NIDEK AFC-230:
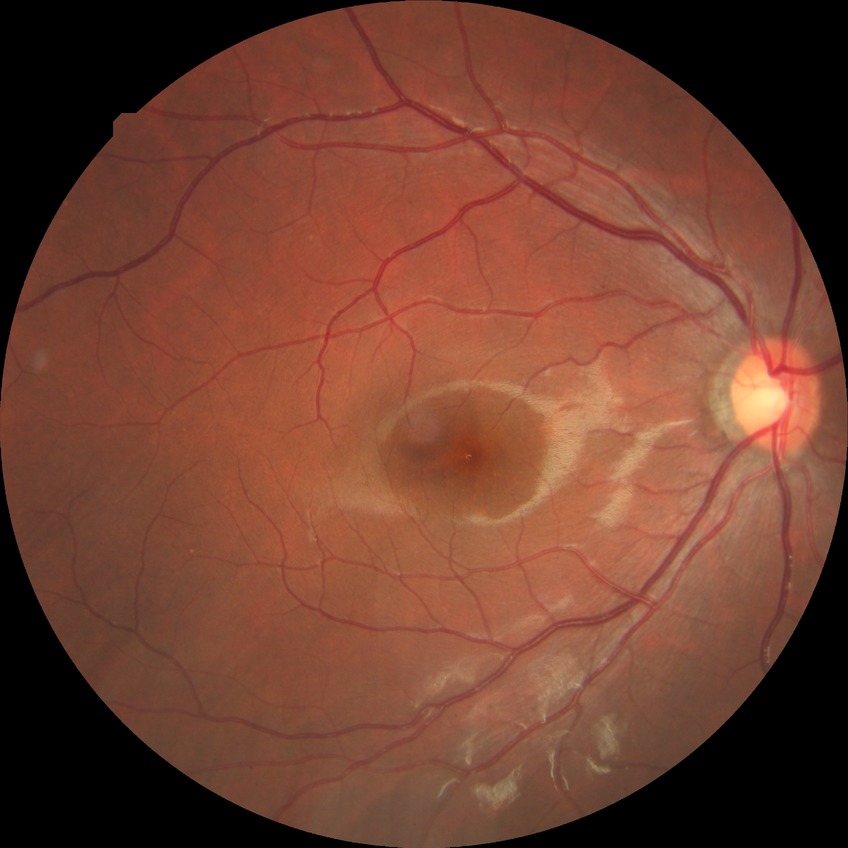
Retinopathy stage is no diabetic retinopathy.